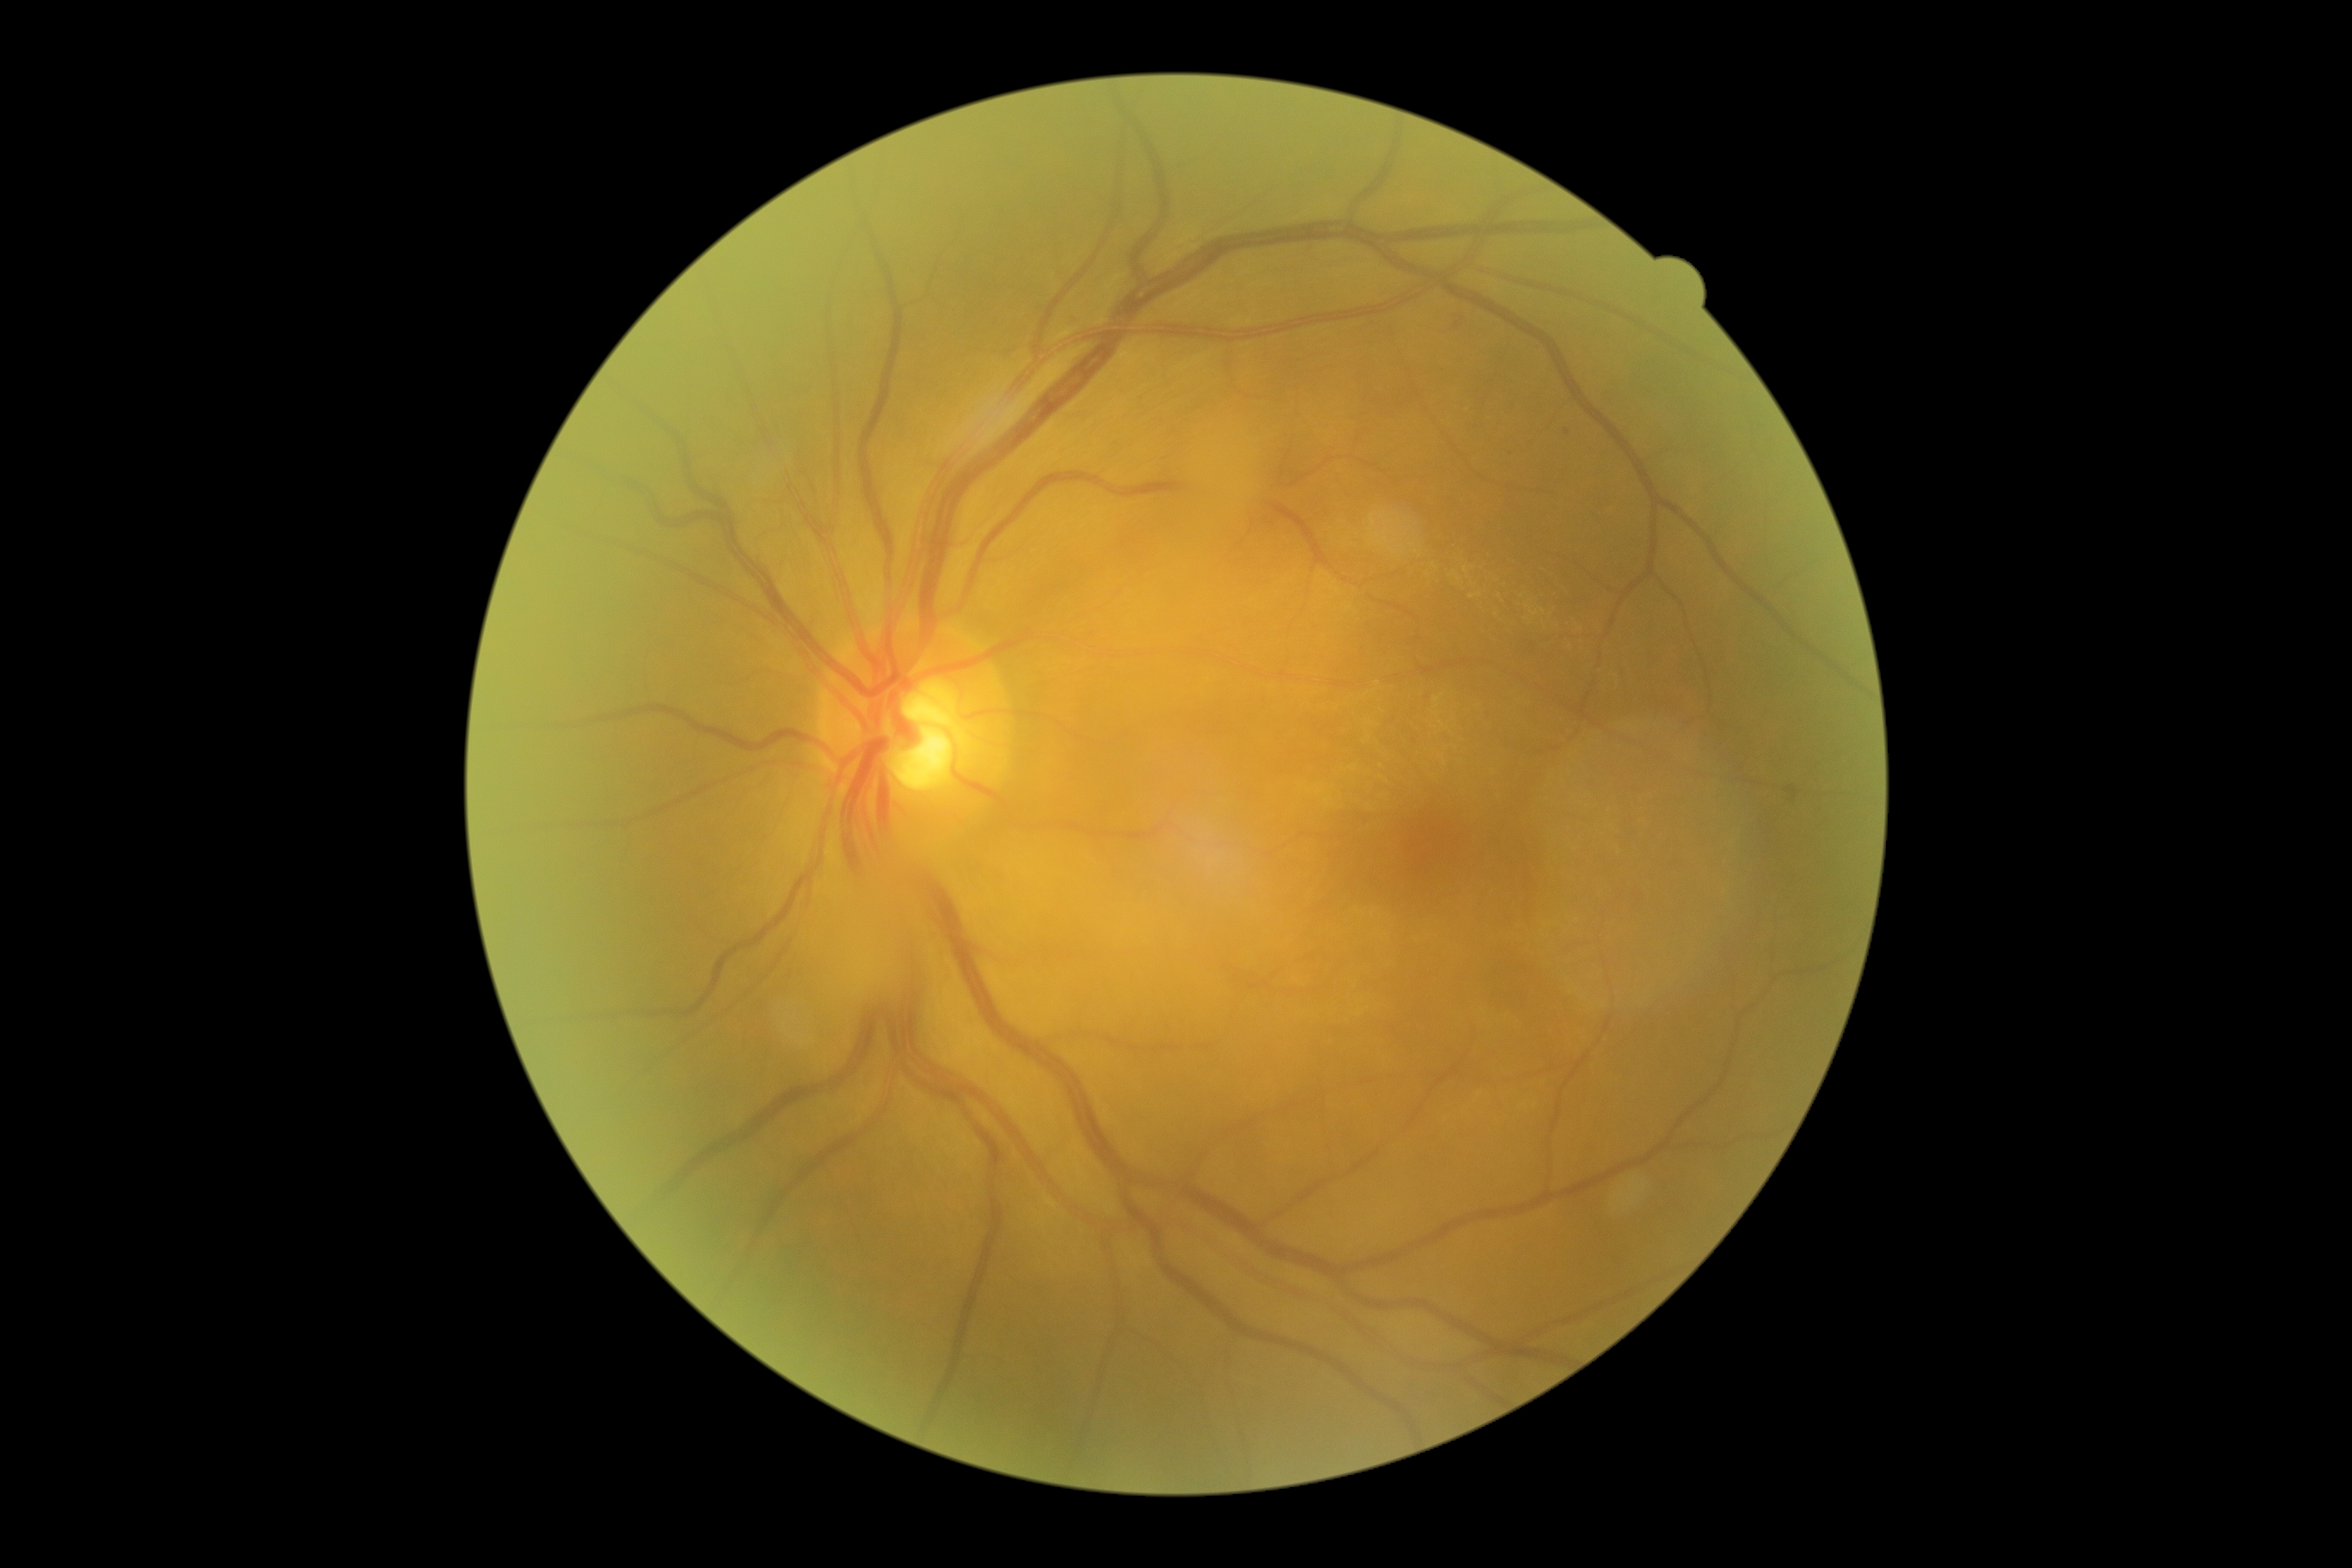

* DR stage: 1